CFP: 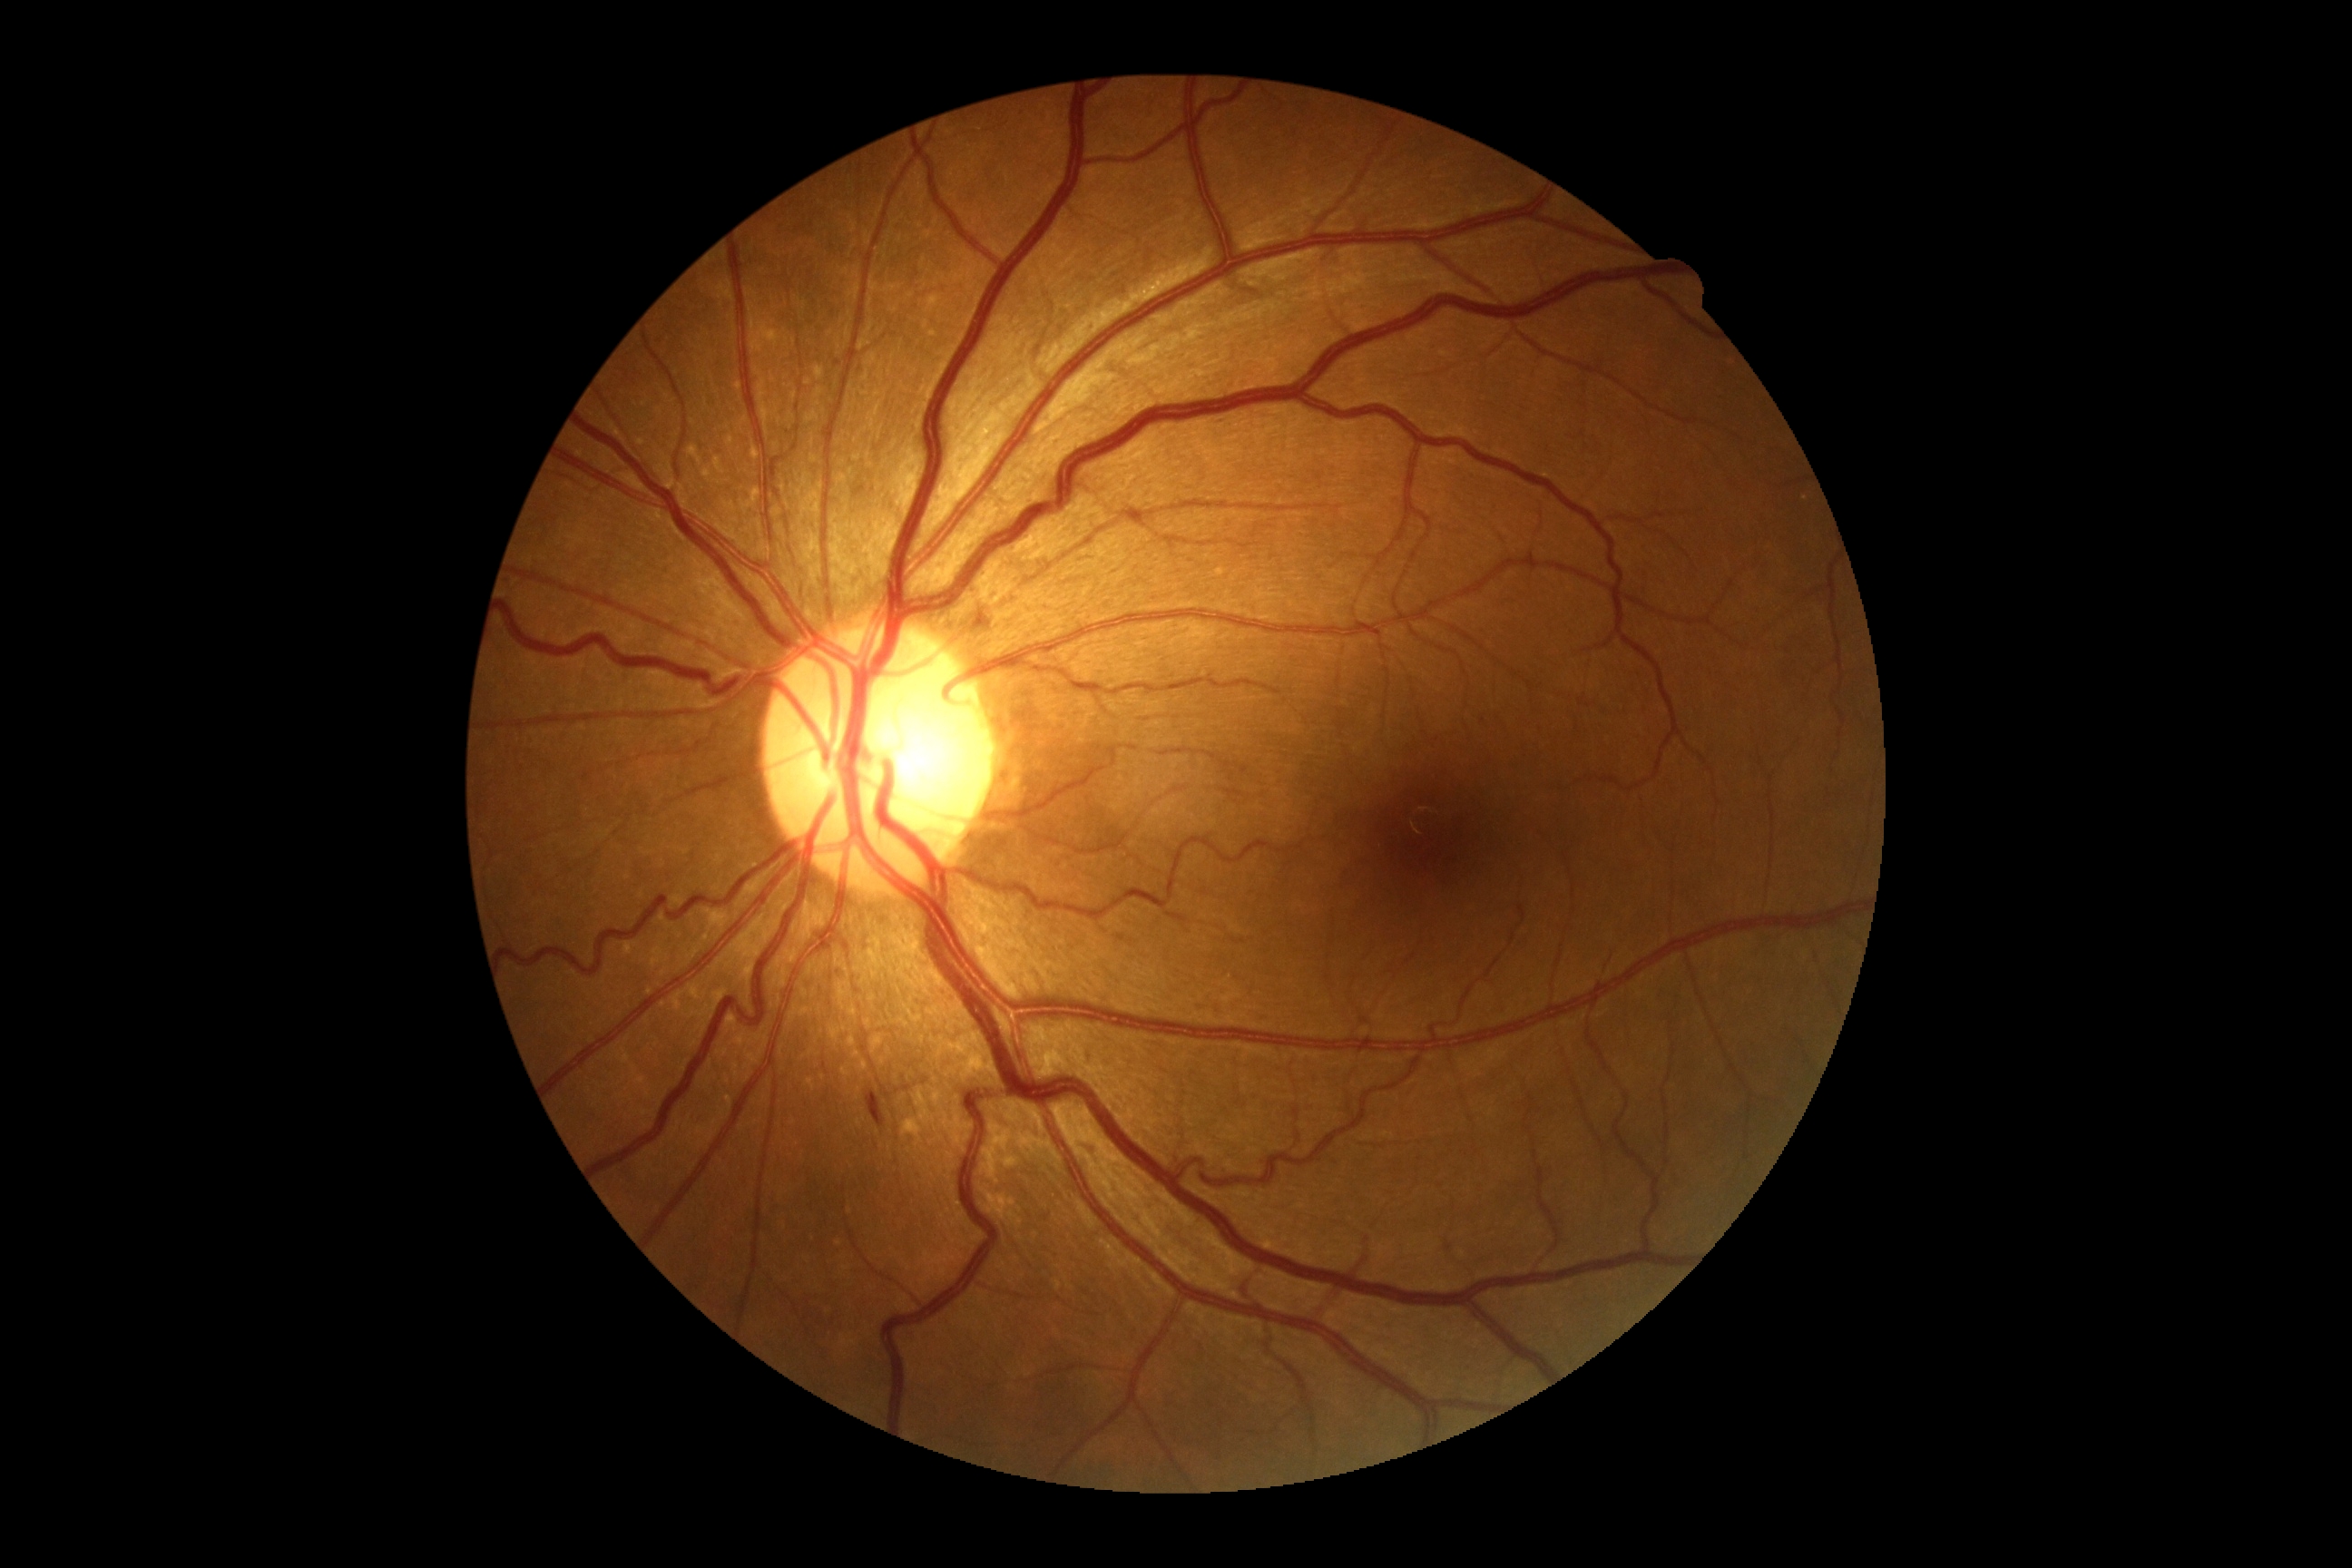

Retinopathy grade is 2/4.
Disease class: non-proliferative diabetic retinopathy.